Pediatric retinal photograph (wide-field); camera: Clarity RetCam 3 (130° FOV): 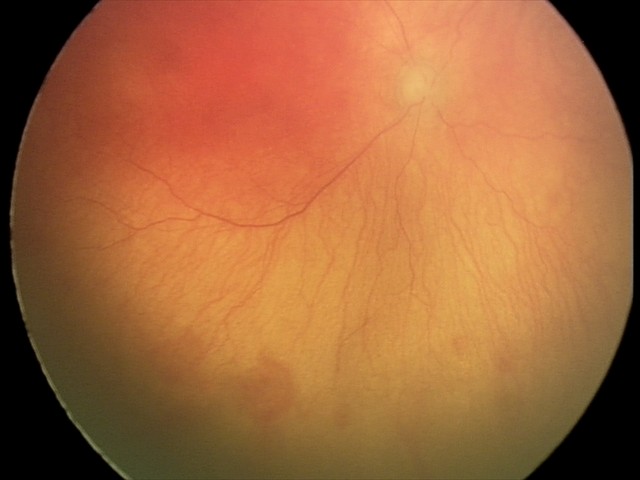

Plus disease present. Examination diagnosed as aggressive retinopathy of prematurity.